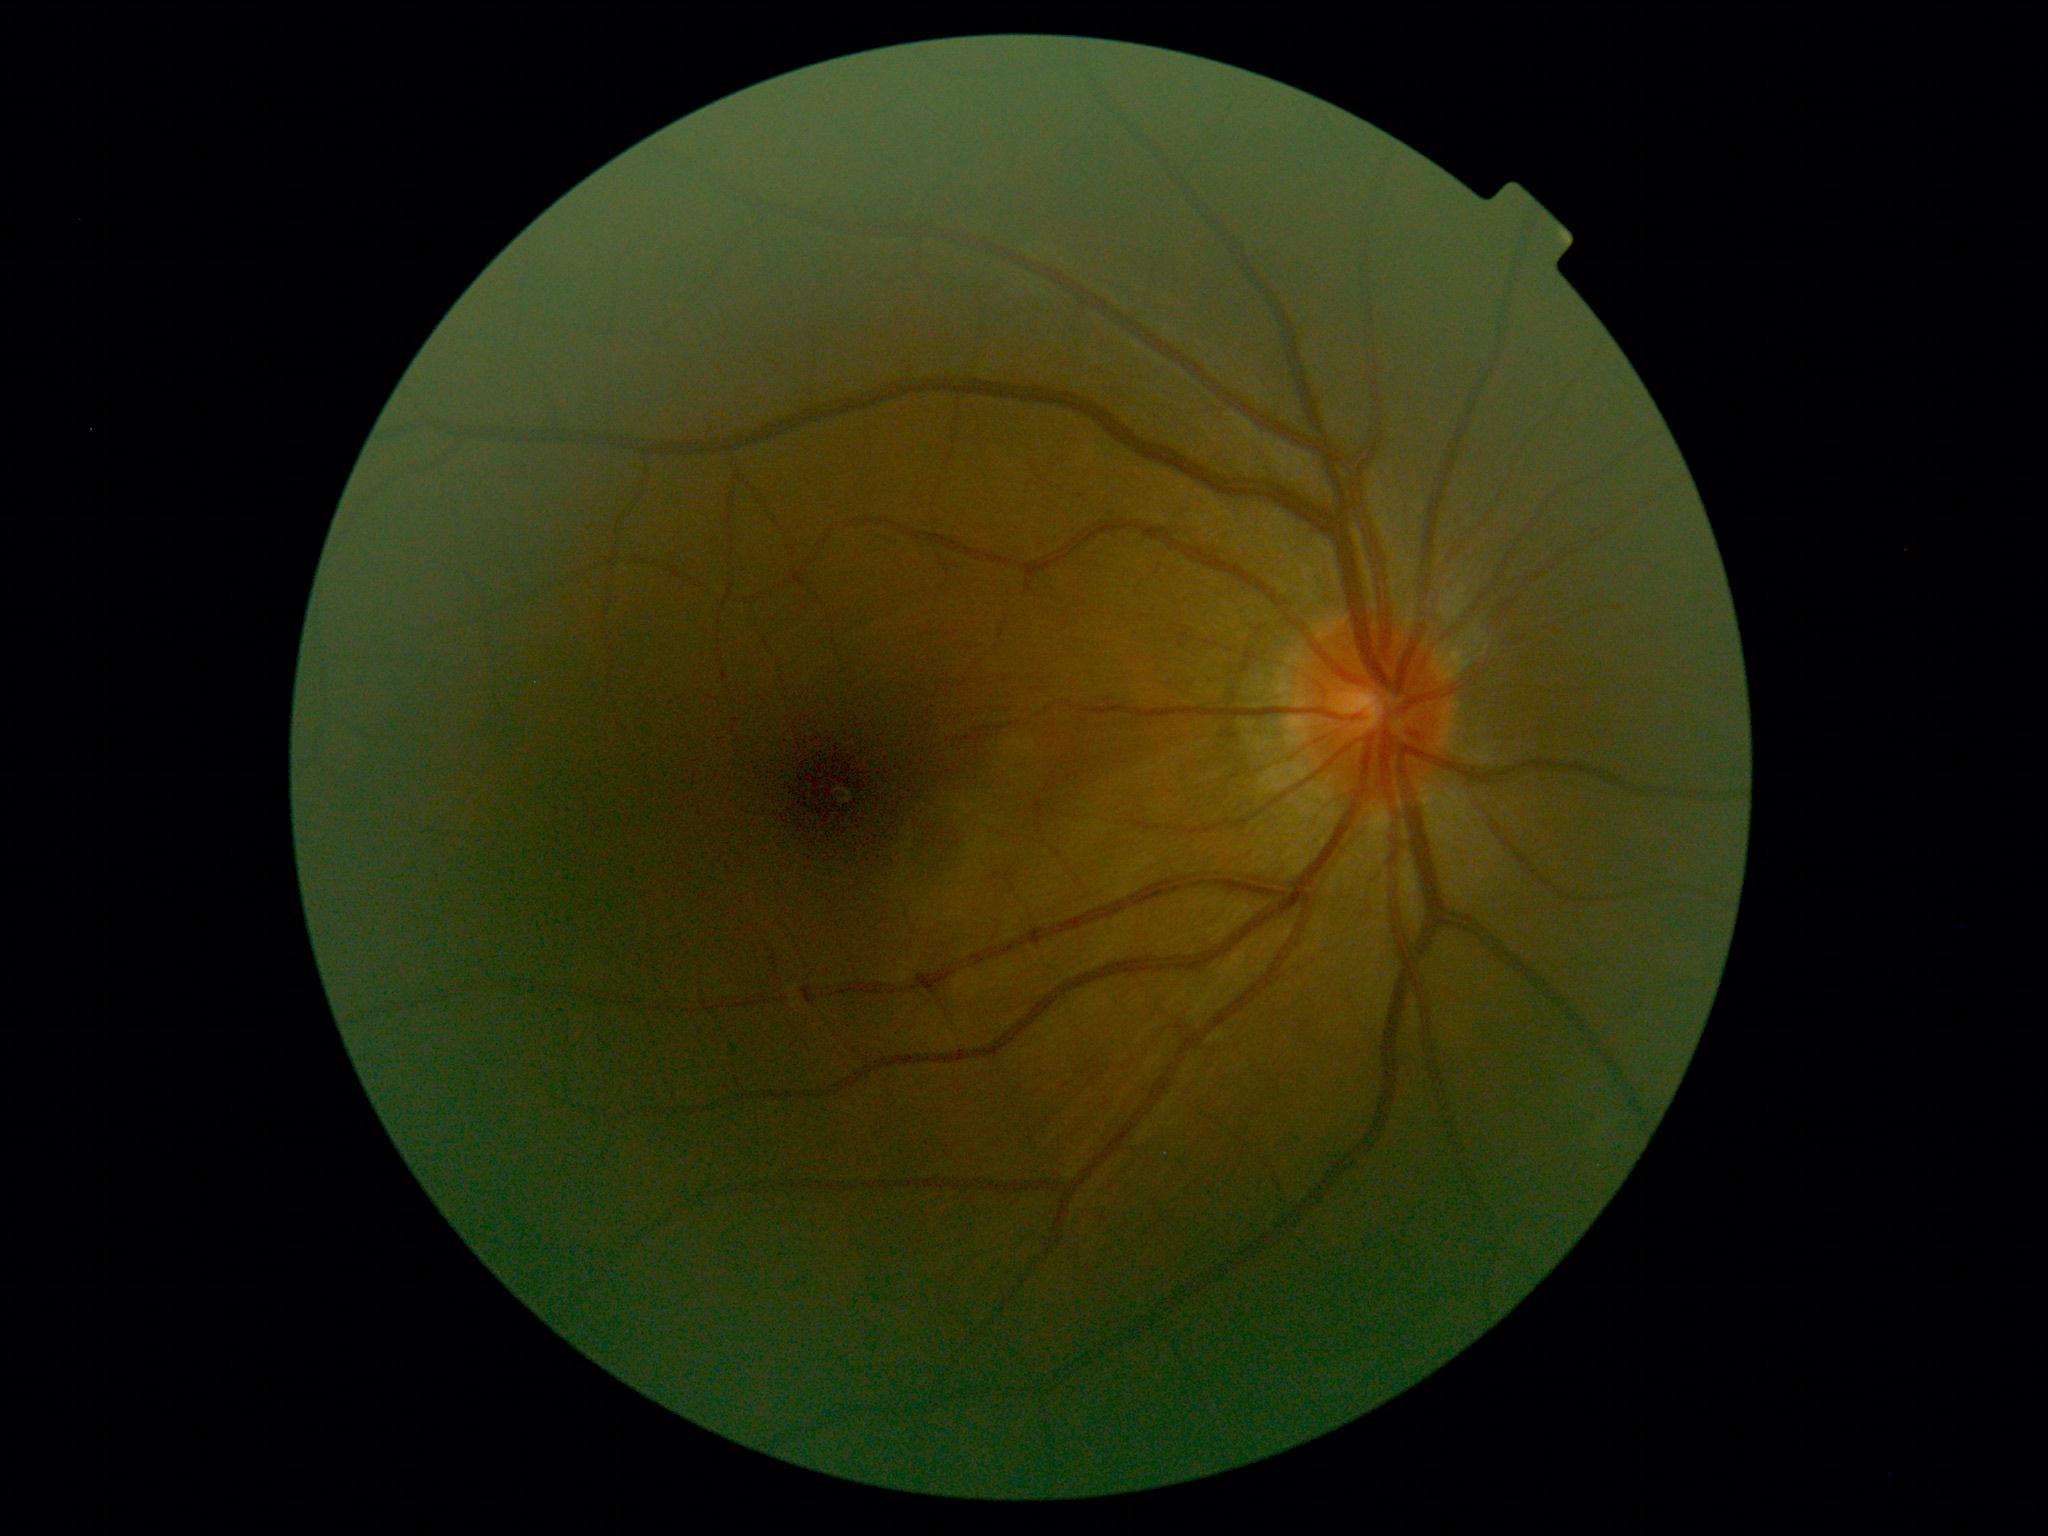 DR severity is 0/4.